1960x1897
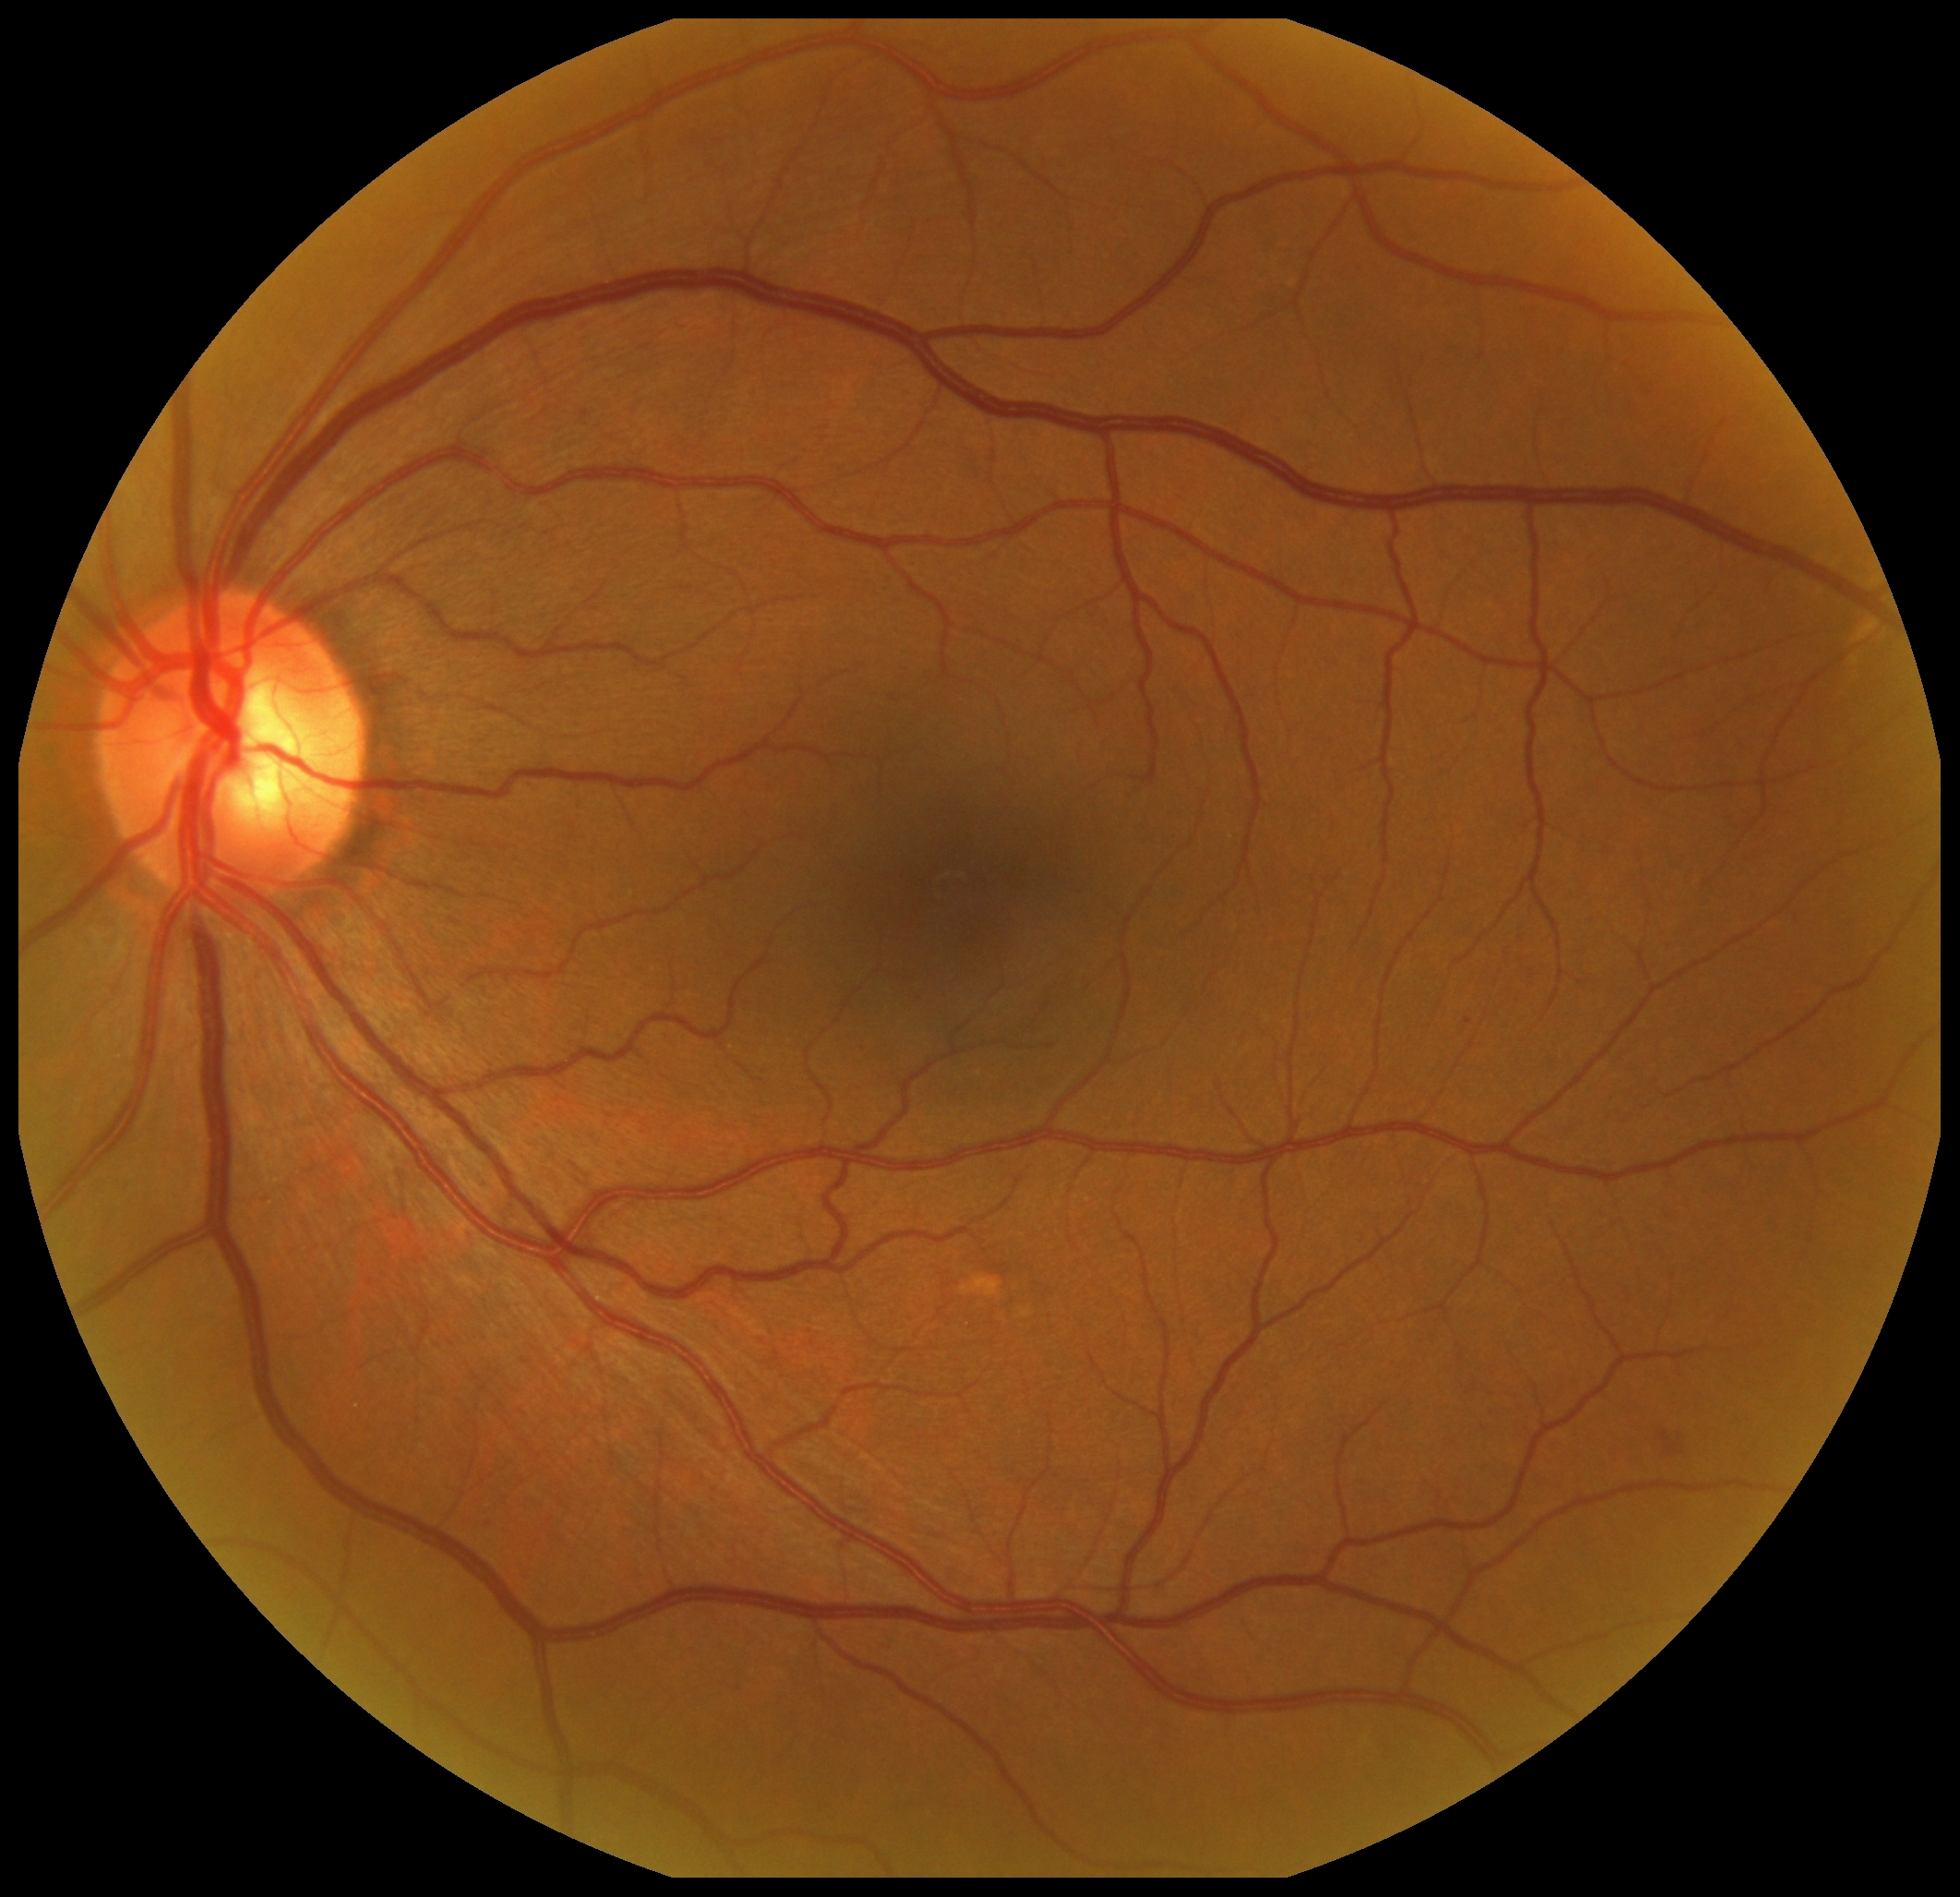

DR grade=2.